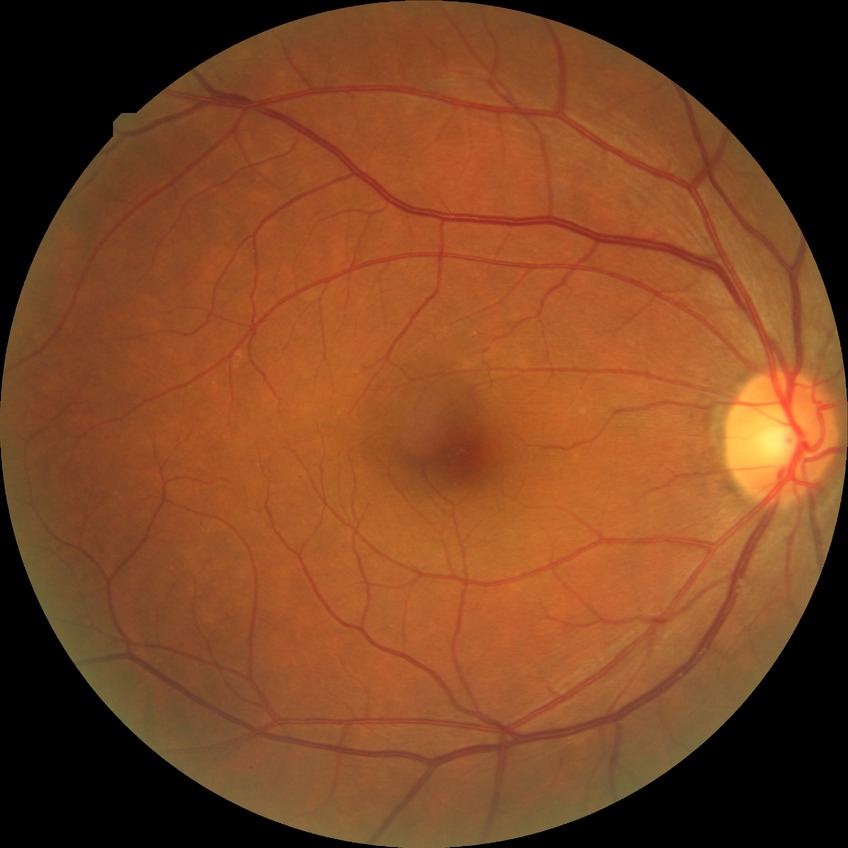
diabetic retinopathy (DR)@no diabetic retinopathy (NDR).